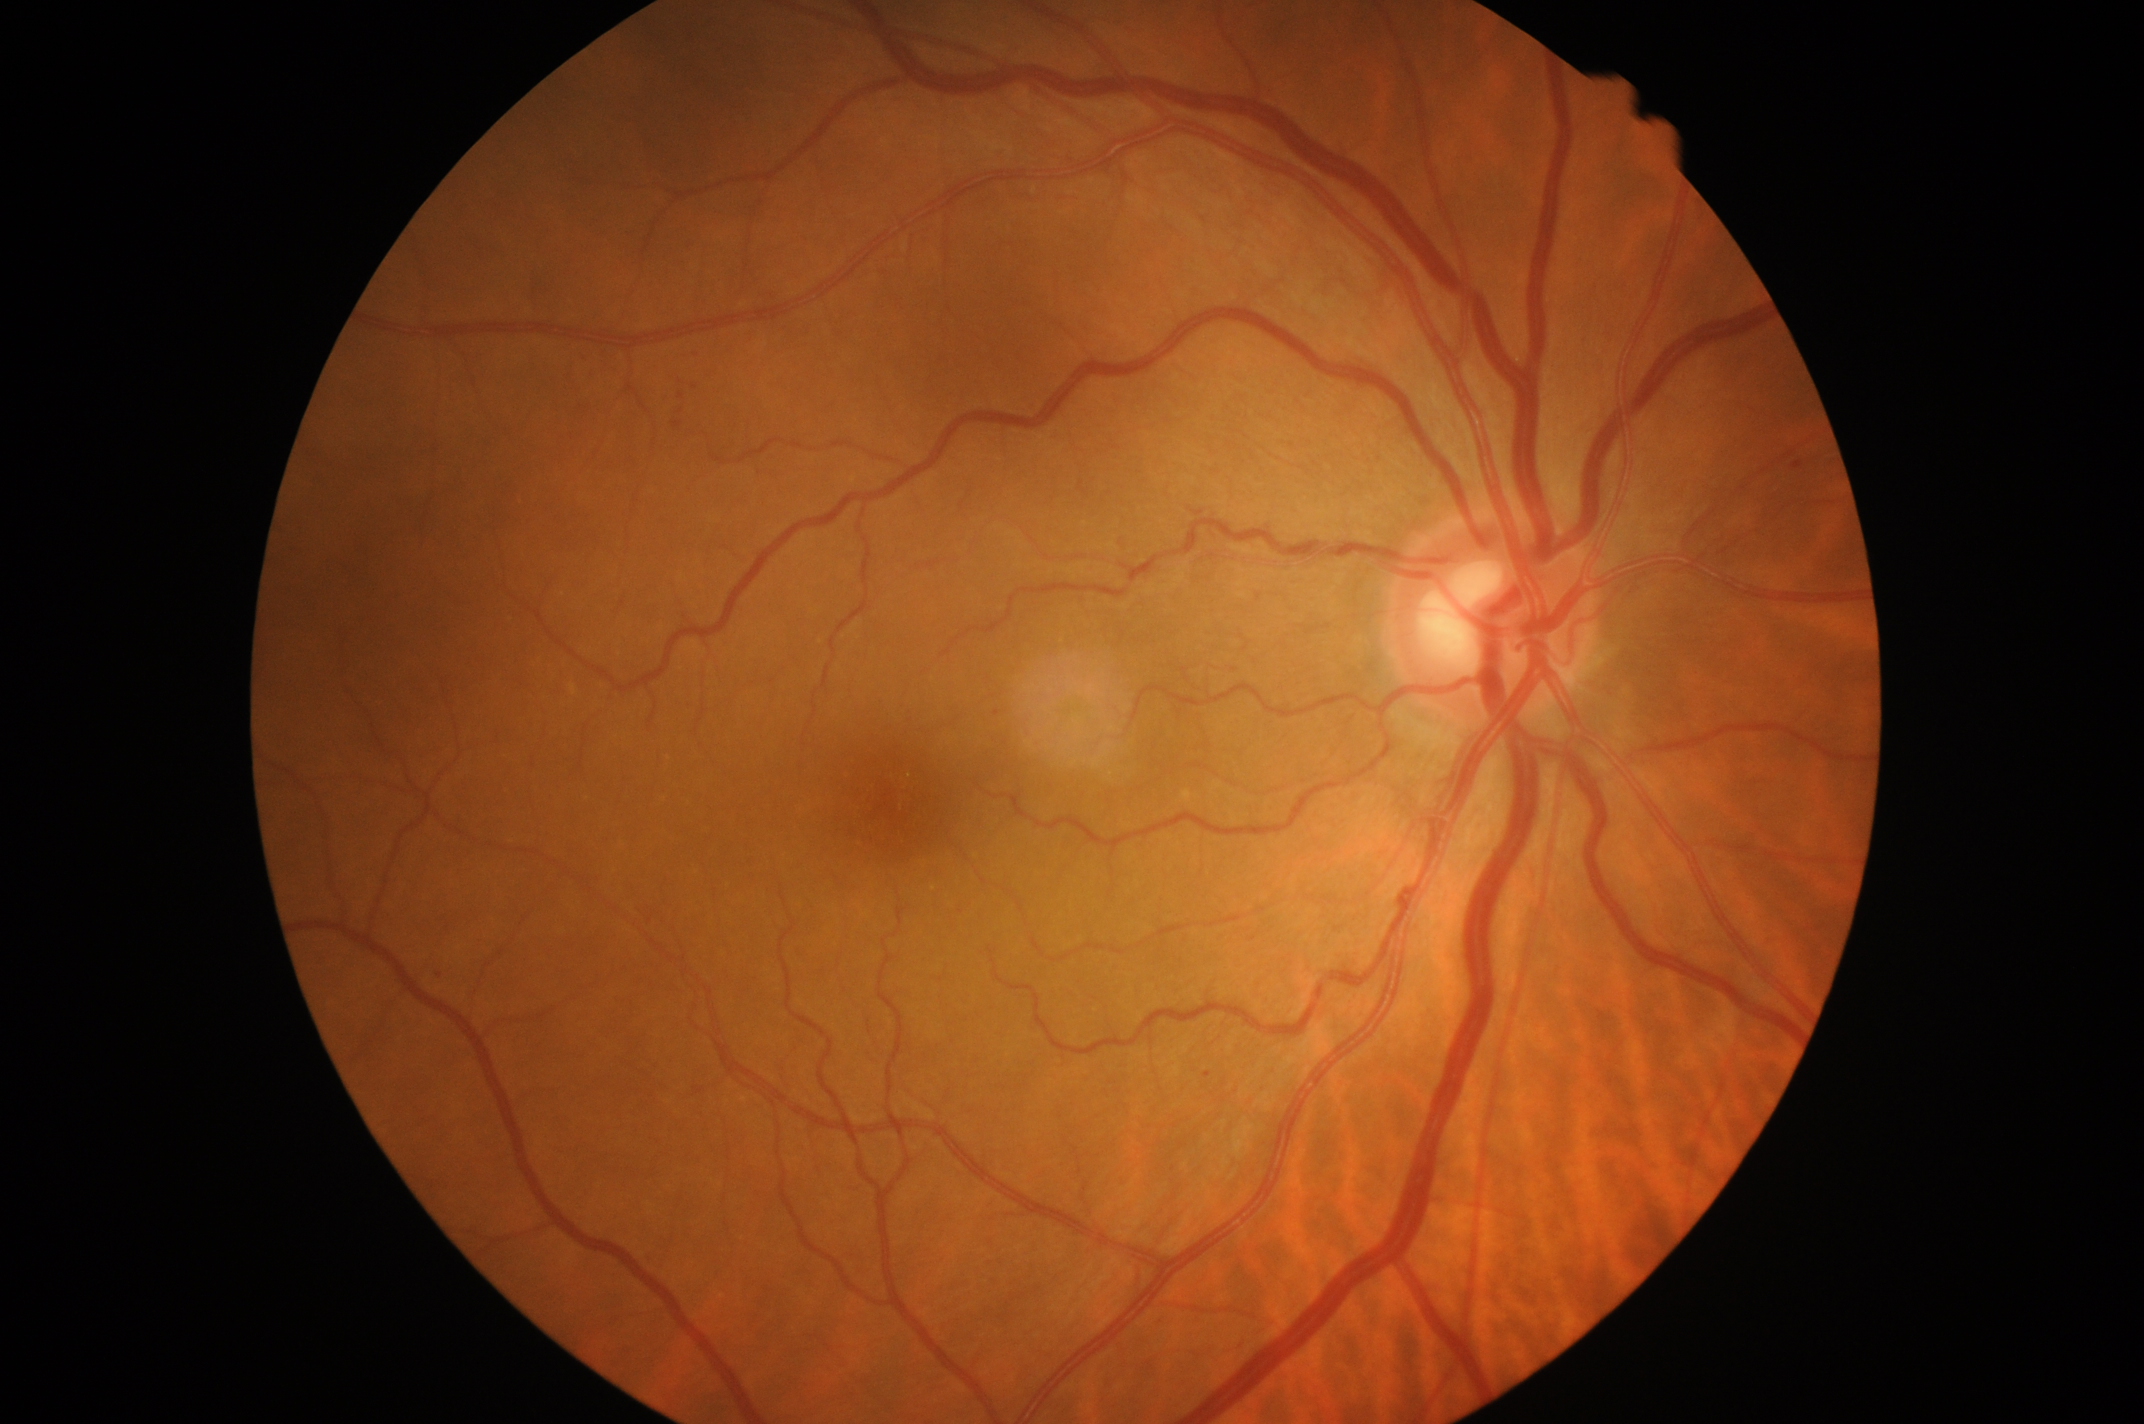 Annotations:
* DR severity: grade 1 (mild NPDR)